1440x1080 · wide-field fundus photograph of an infant · captured with the Natus RetCam Envision (130° field of view):
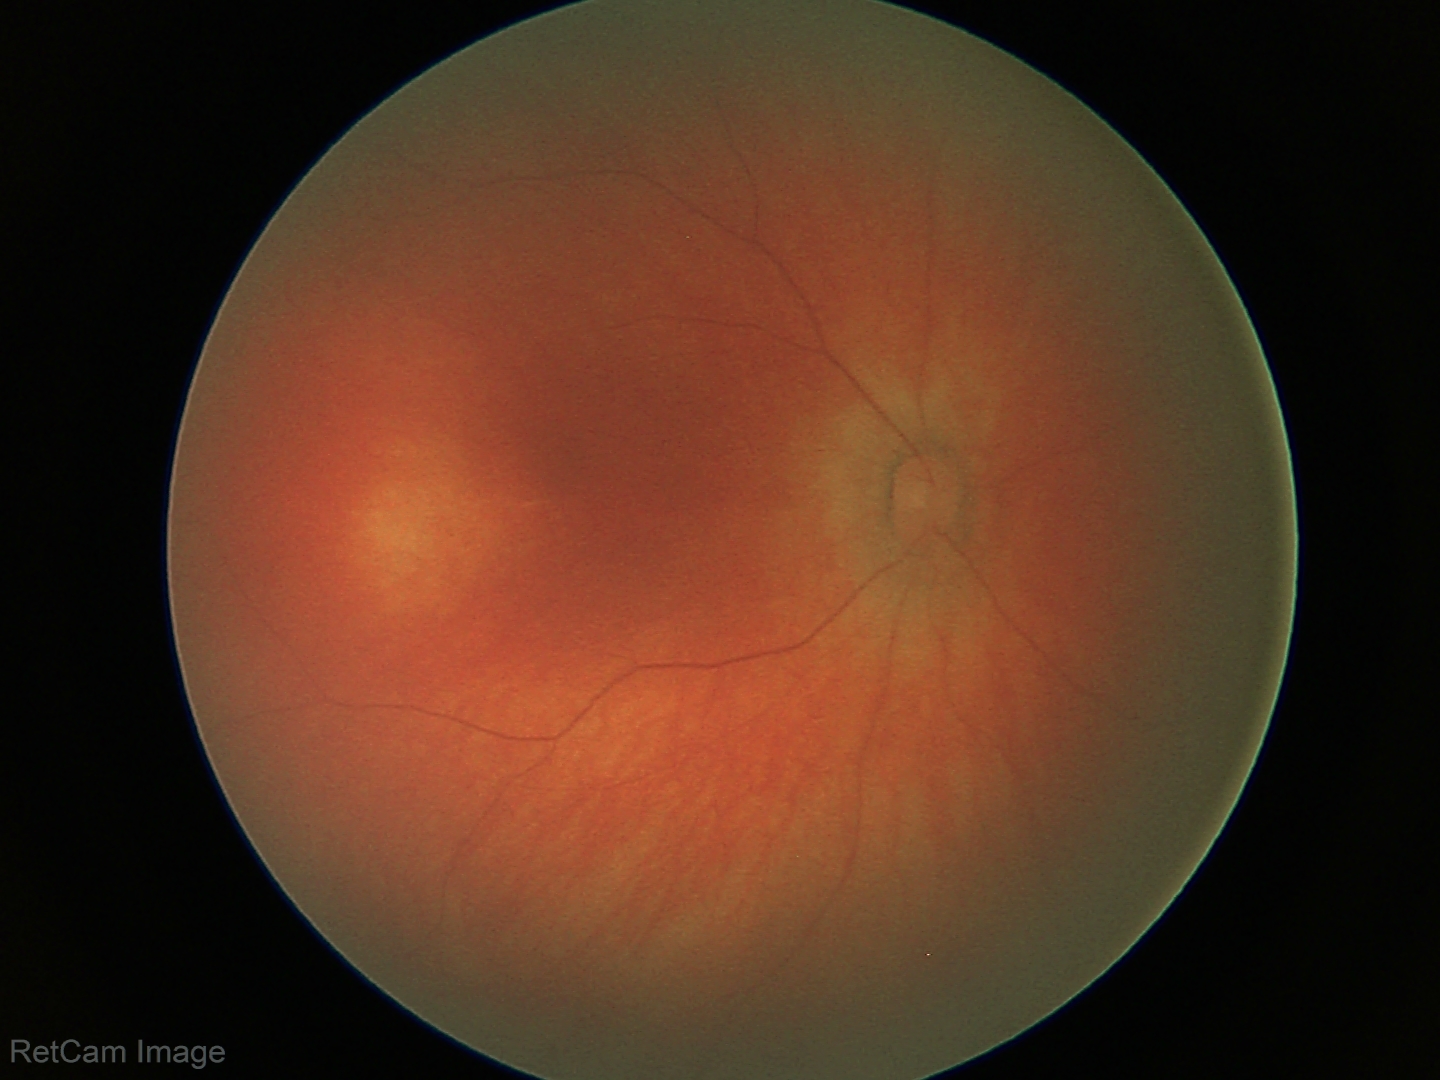 Screening examination with no abnormal retinal findings.